Graded on the modified Davis scale. Acquired with a NIDEK AFC-230:
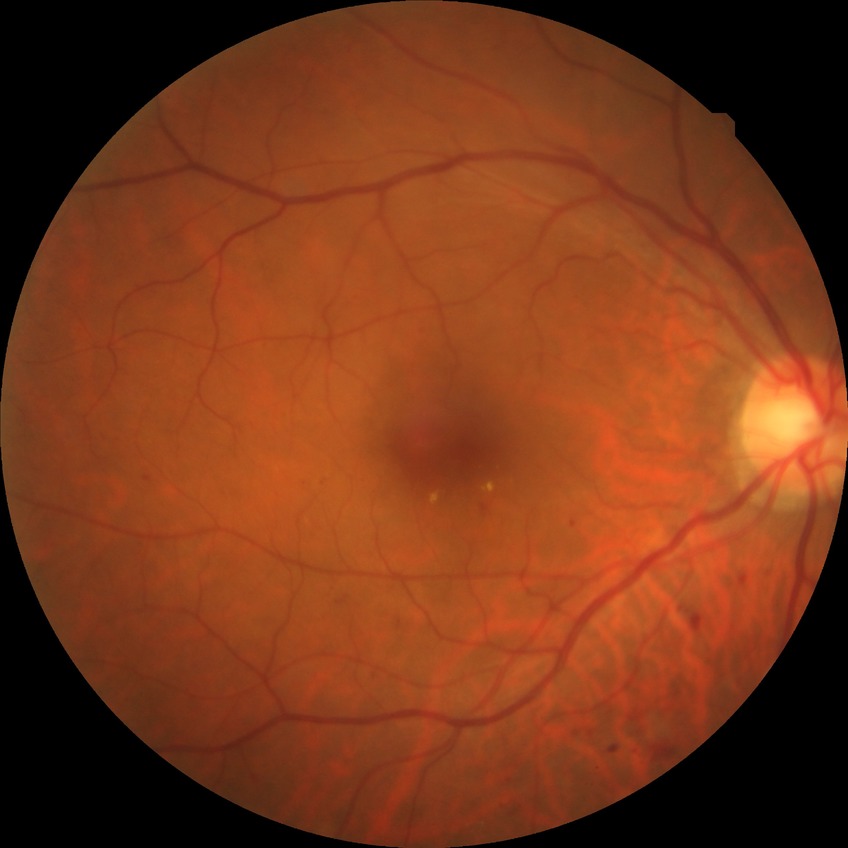

diabetic retinopathy (DR): SDR (simple diabetic retinopathy).